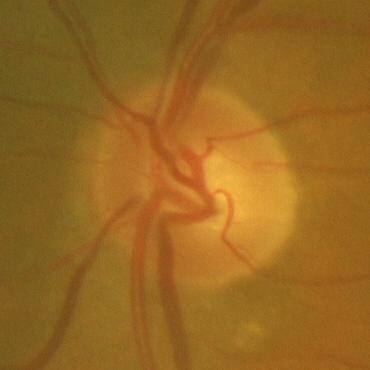
Finding = no evidence of glaucoma.